Color fundus photograph from a handheld portable camera.
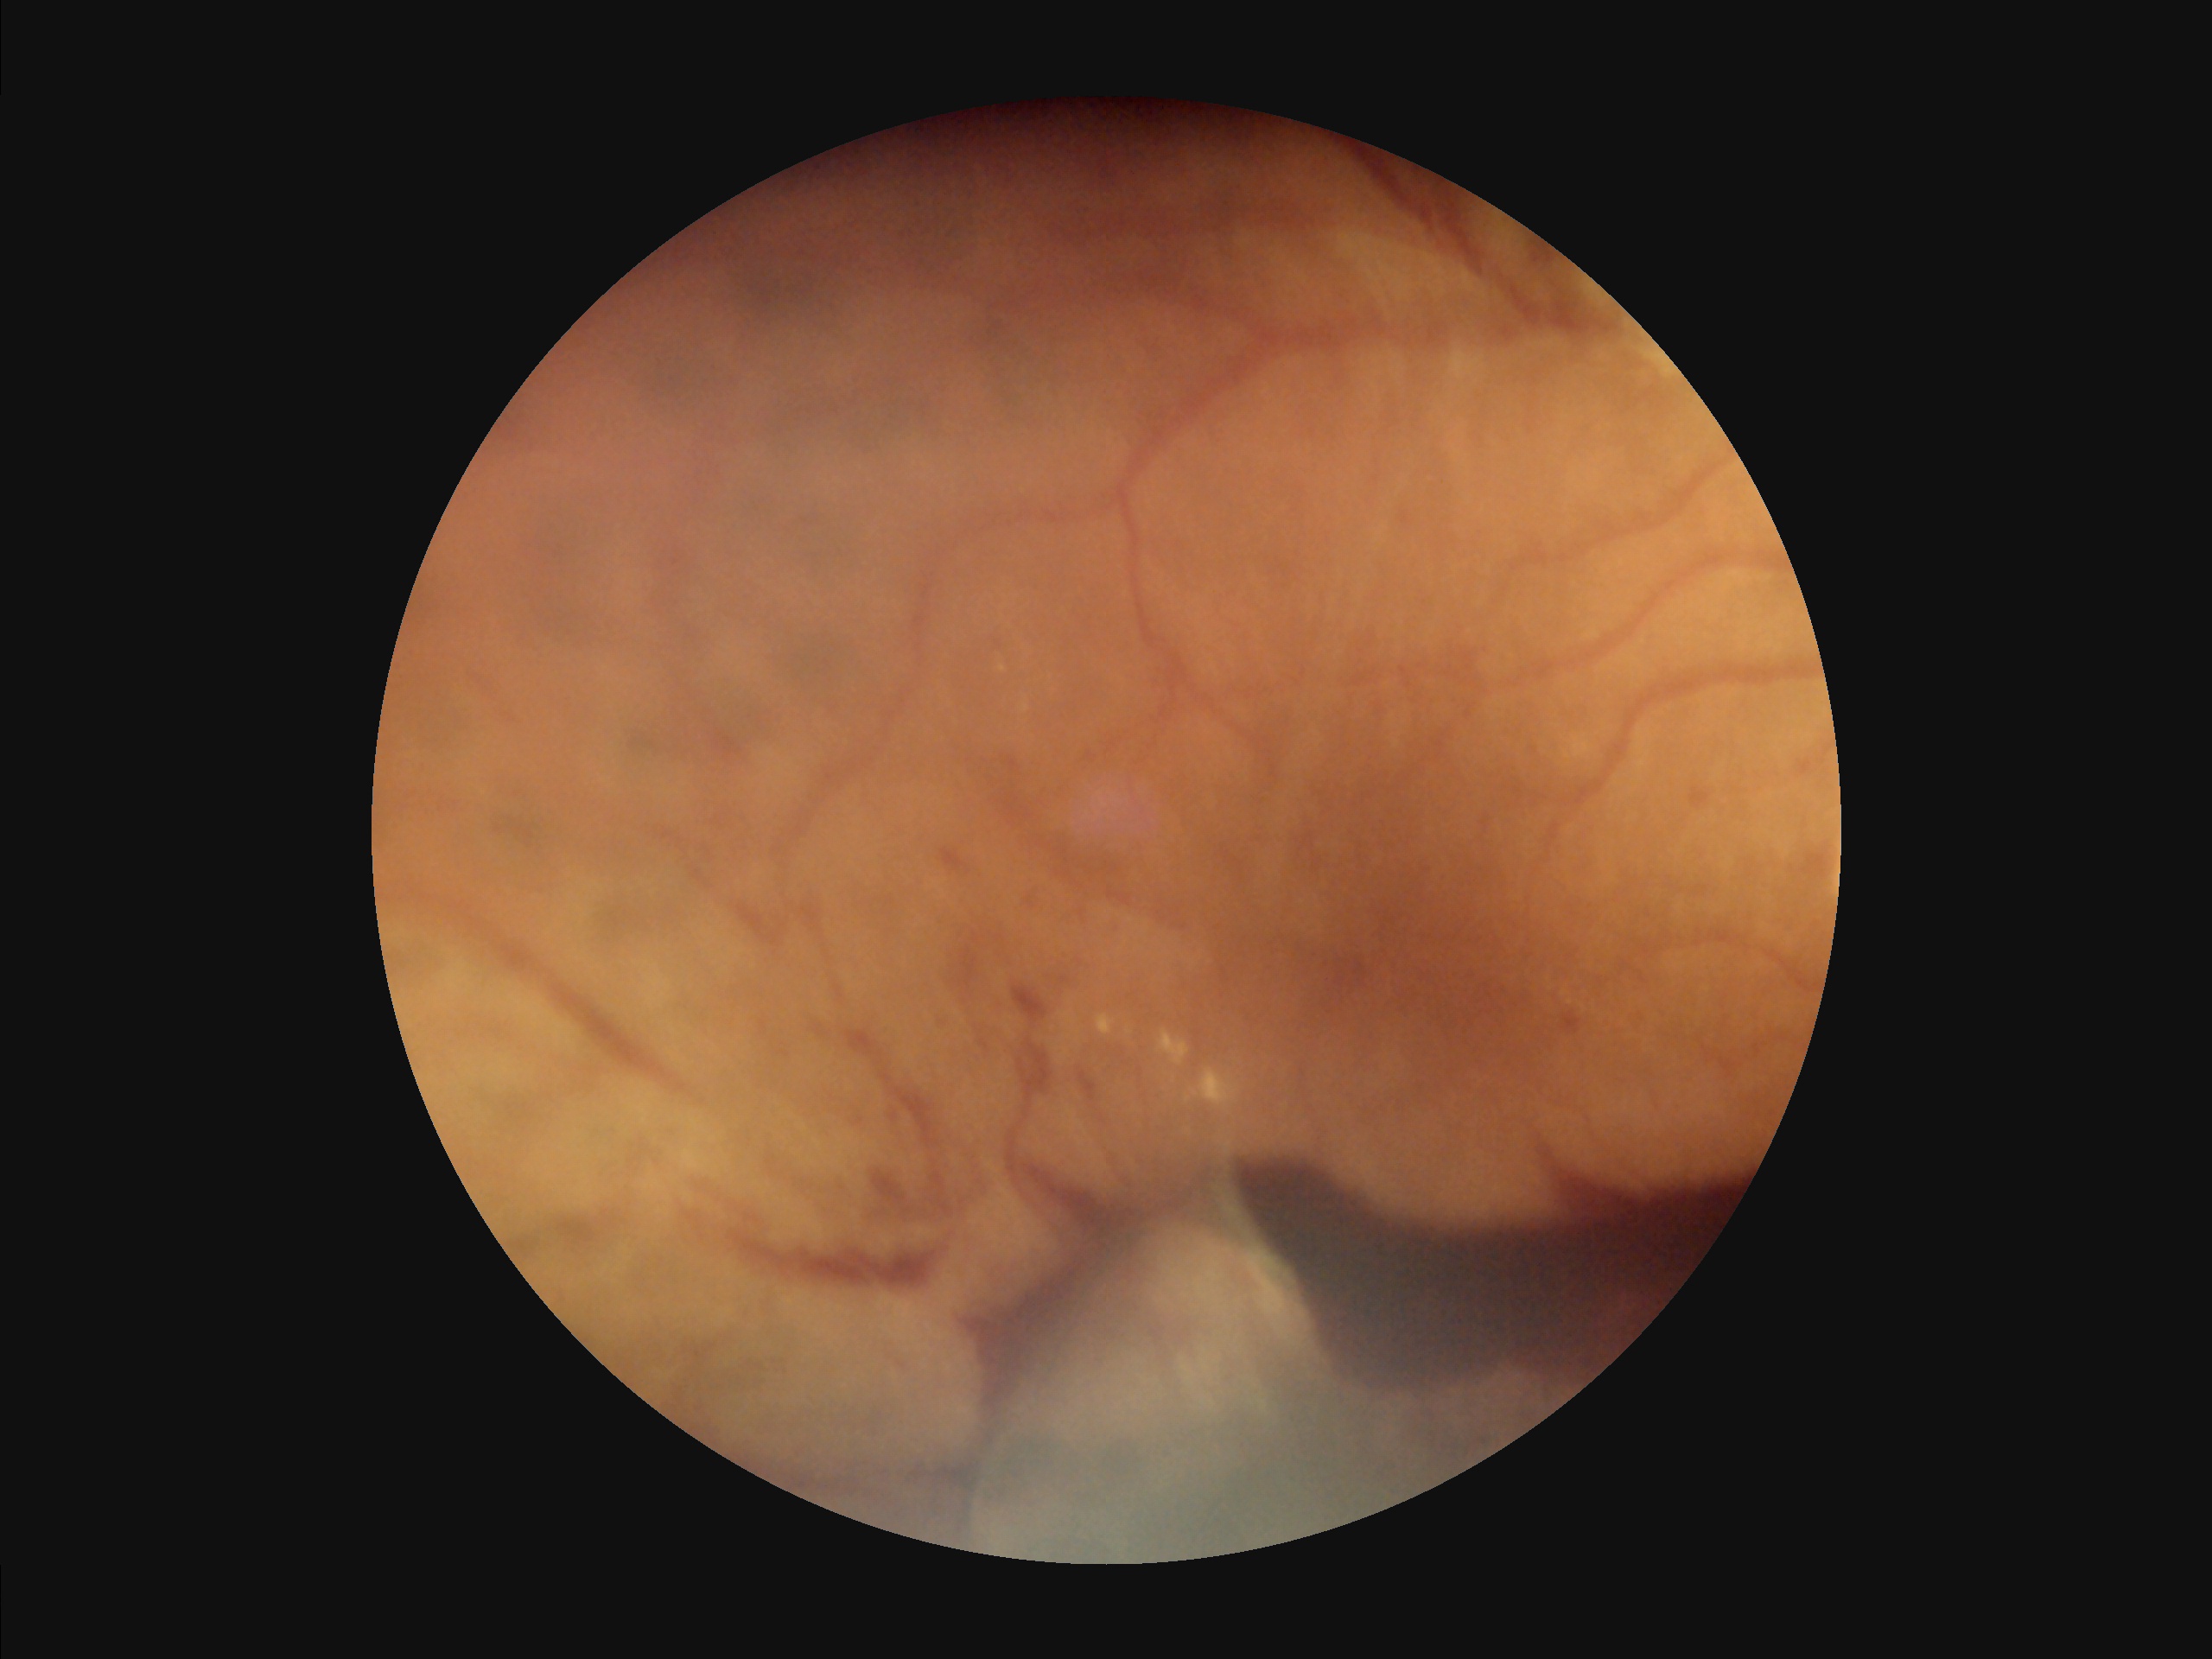
{"contrast": "low", "overall_quality": "suboptimal", "clarity": "reduced", "illumination": "satisfactory"}